FOV: 45 degrees:
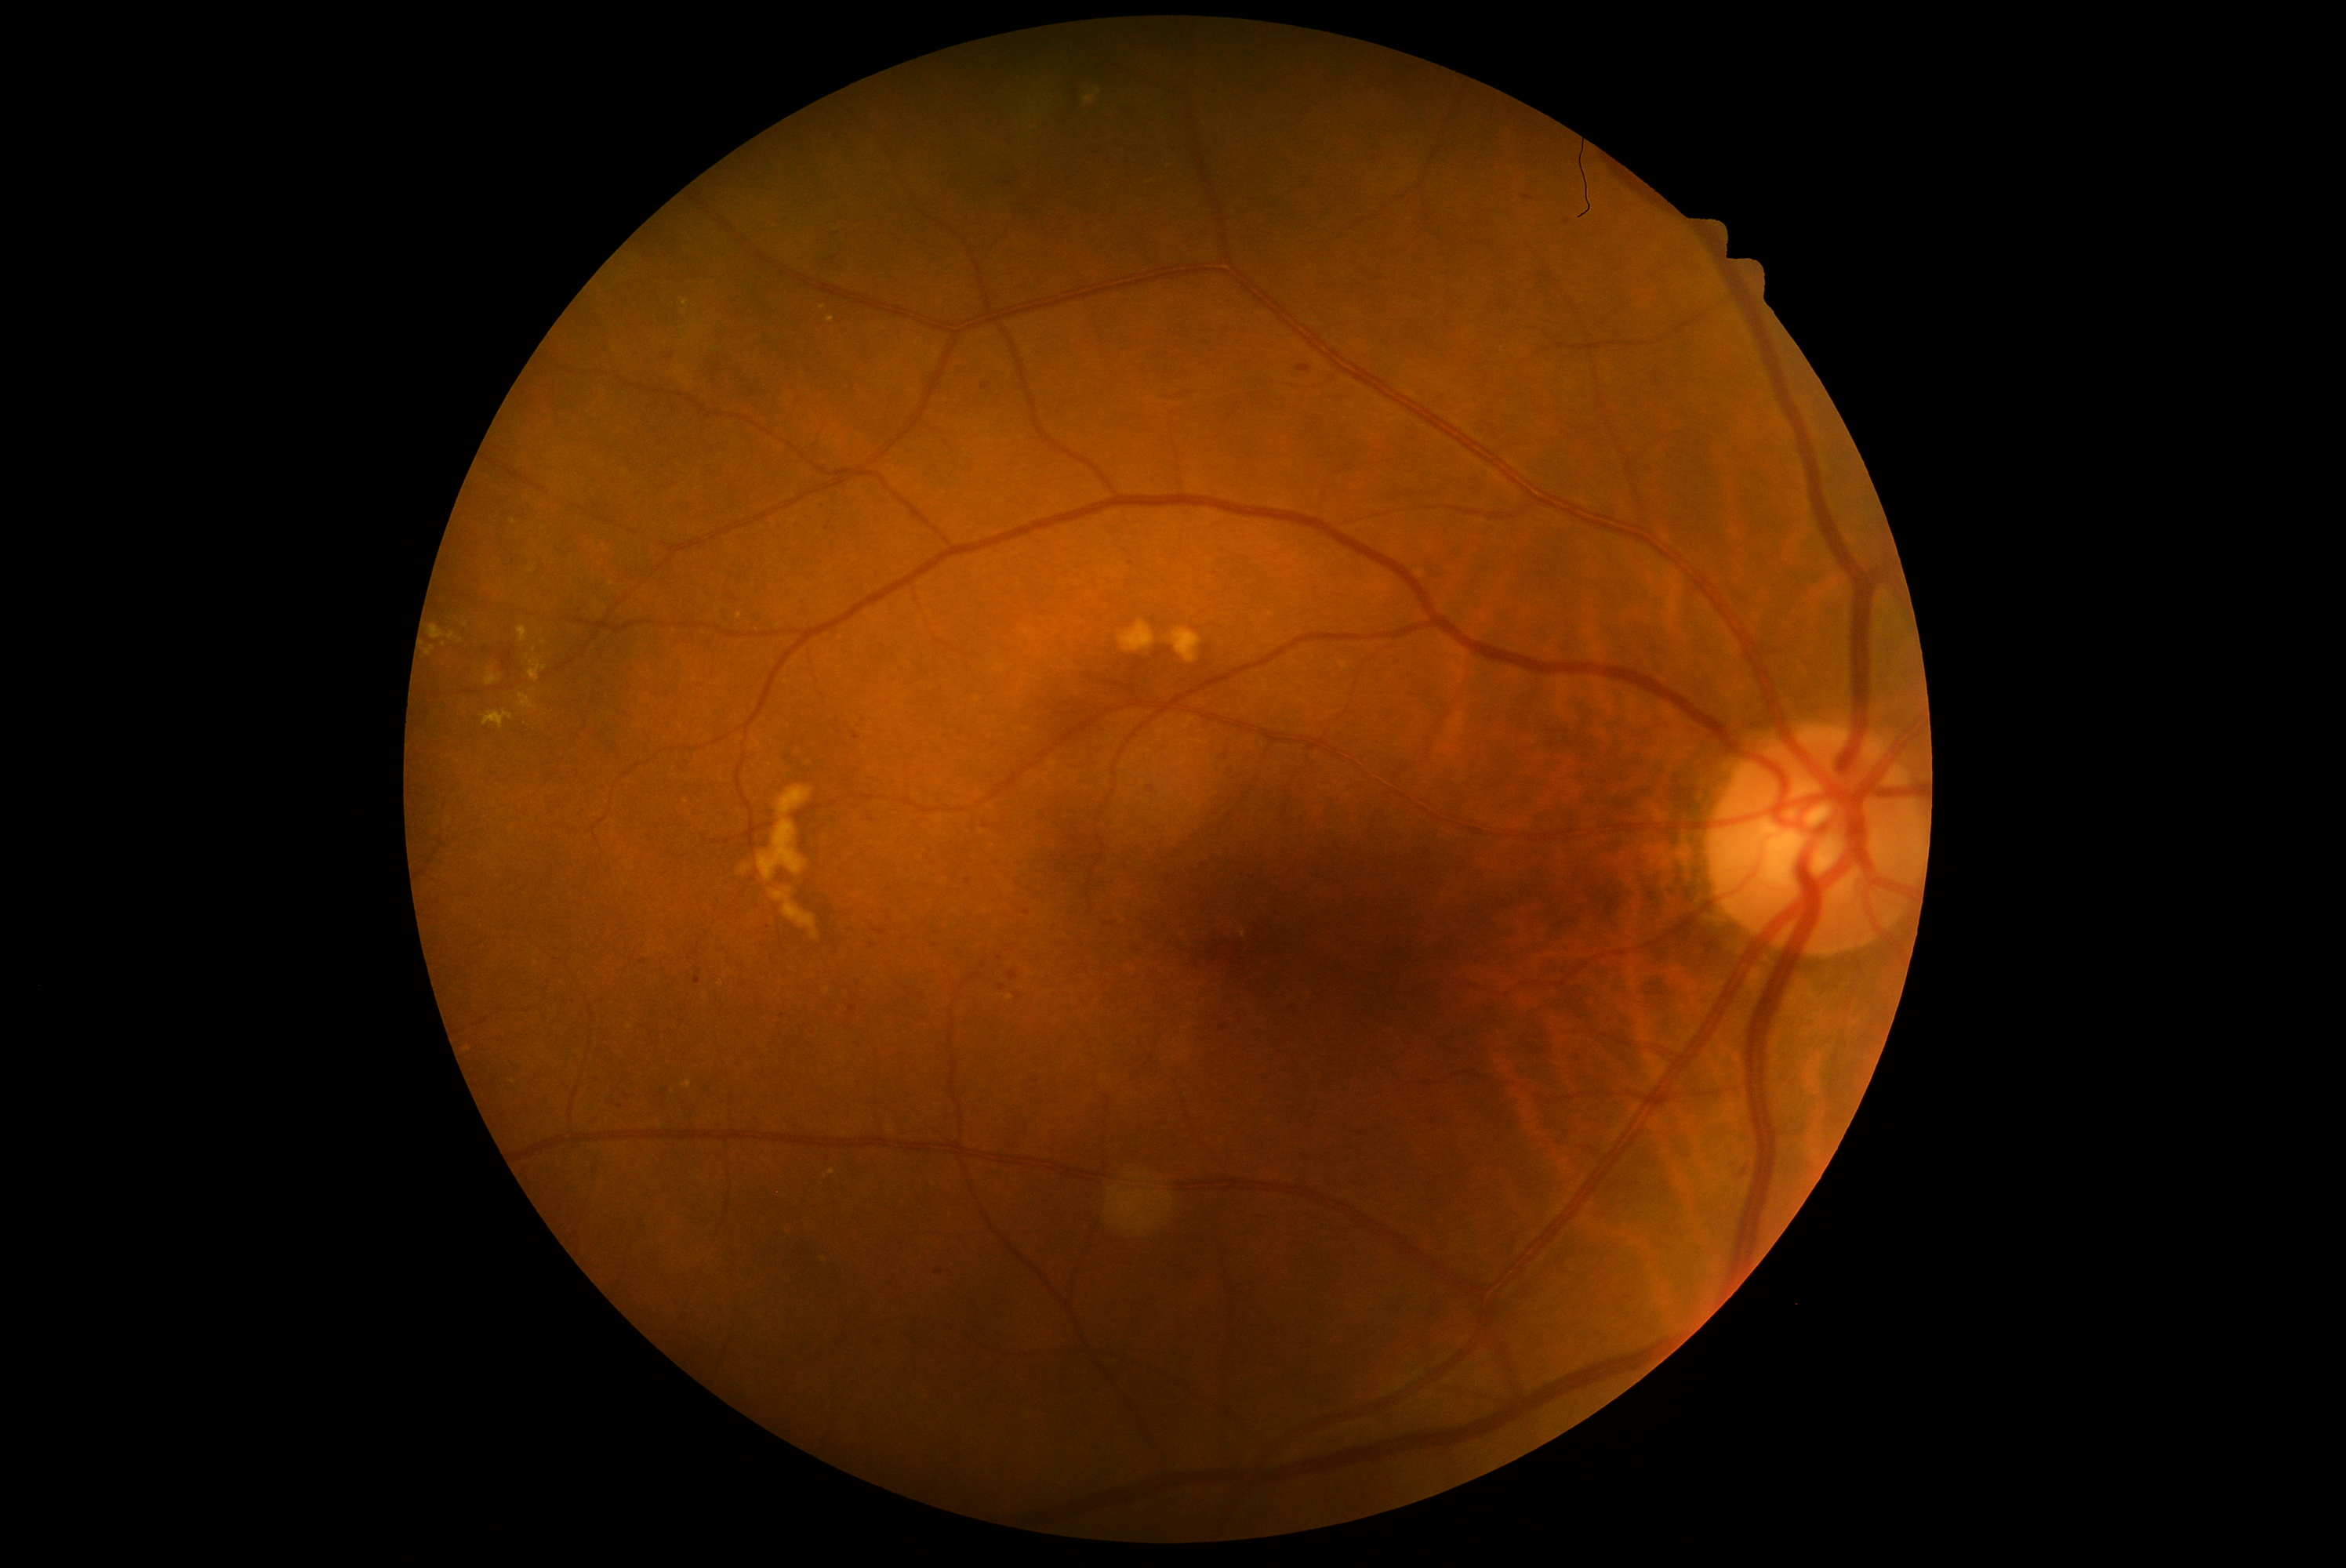
Diabetic retinopathy grade: 2; non-proliferative diabetic retinopathy
Lesions identified (partial list):
hemorrhages (more not shown): <bbox>989, 165, 1030, 191</bbox> | <bbox>998, 984, 1006, 993</bbox> | <bbox>829, 255, 837, 263</bbox> | <bbox>876, 931, 885, 935</bbox> | <bbox>777, 1329, 793, 1341</bbox> | <bbox>816, 1285, 840, 1302</bbox> | <bbox>1058, 214, 1069, 225</bbox> | <bbox>830, 230, 841, 238</bbox> | <bbox>694, 971, 702, 984</bbox> | <bbox>1069, 85, 1081, 107</bbox>
Small hemorrhages near point(840, 262) | point(968, 882) | point(937, 933) | point(828, 529) | point(769, 927) | point(1027, 912)
hard exudates (more not shown): <bbox>827, 318, 835, 324</bbox> | <bbox>482, 711, 514, 730</bbox> | <bbox>448, 633, 463, 644</bbox> | <bbox>427, 647, 435, 656</bbox> | <bbox>518, 694, 539, 713</bbox> | <bbox>430, 625, 445, 641</bbox>
Small hard exudates near point(683, 312) | point(543, 528) | point(514, 522) | point(822, 309) | point(740, 616) | point(444, 645)
soft exudates: none detected
microaneurysms: none detected